35° FOV before cropping, fundus photograph cropped around the optic nerve head.
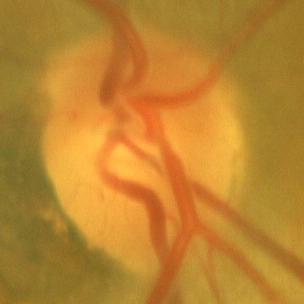

Q: Is there glaucomatous optic neuropathy?
A: No glaucomatous damage.